Fundus photo · 45° field of view · image size 2352x1568
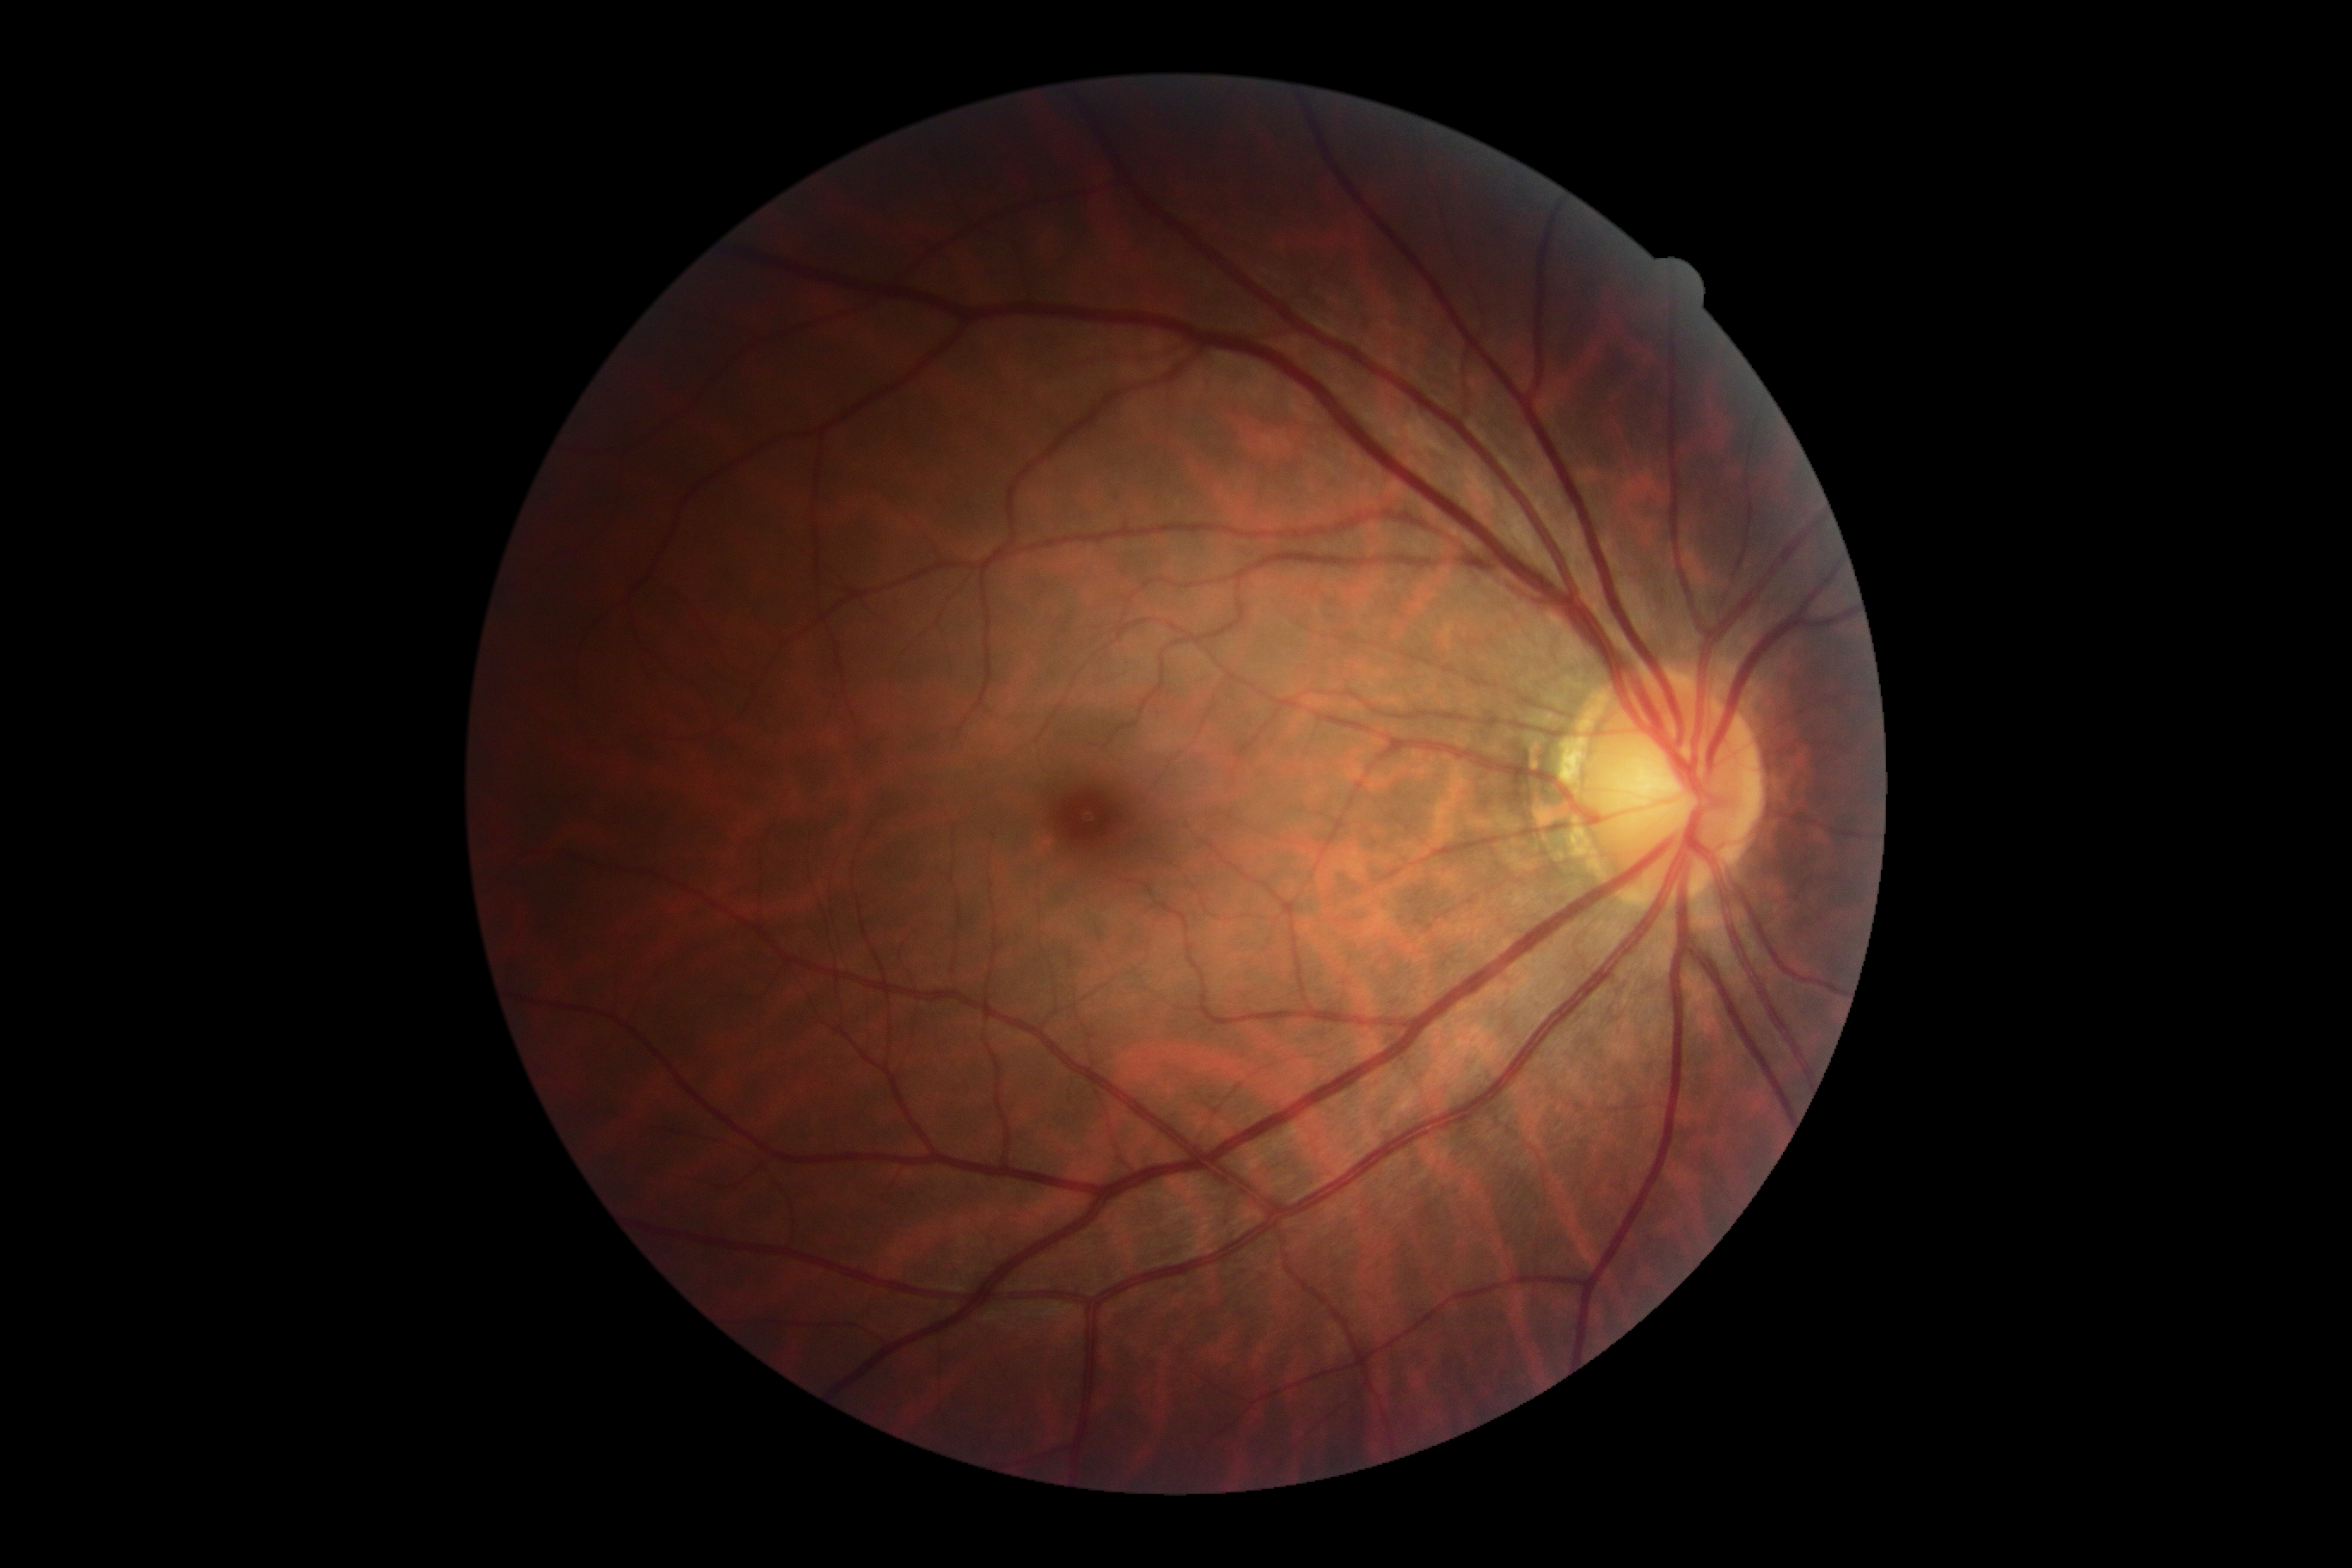

DR is no apparent diabetic retinopathy (grade 0). No diabetic retinal disease findings.